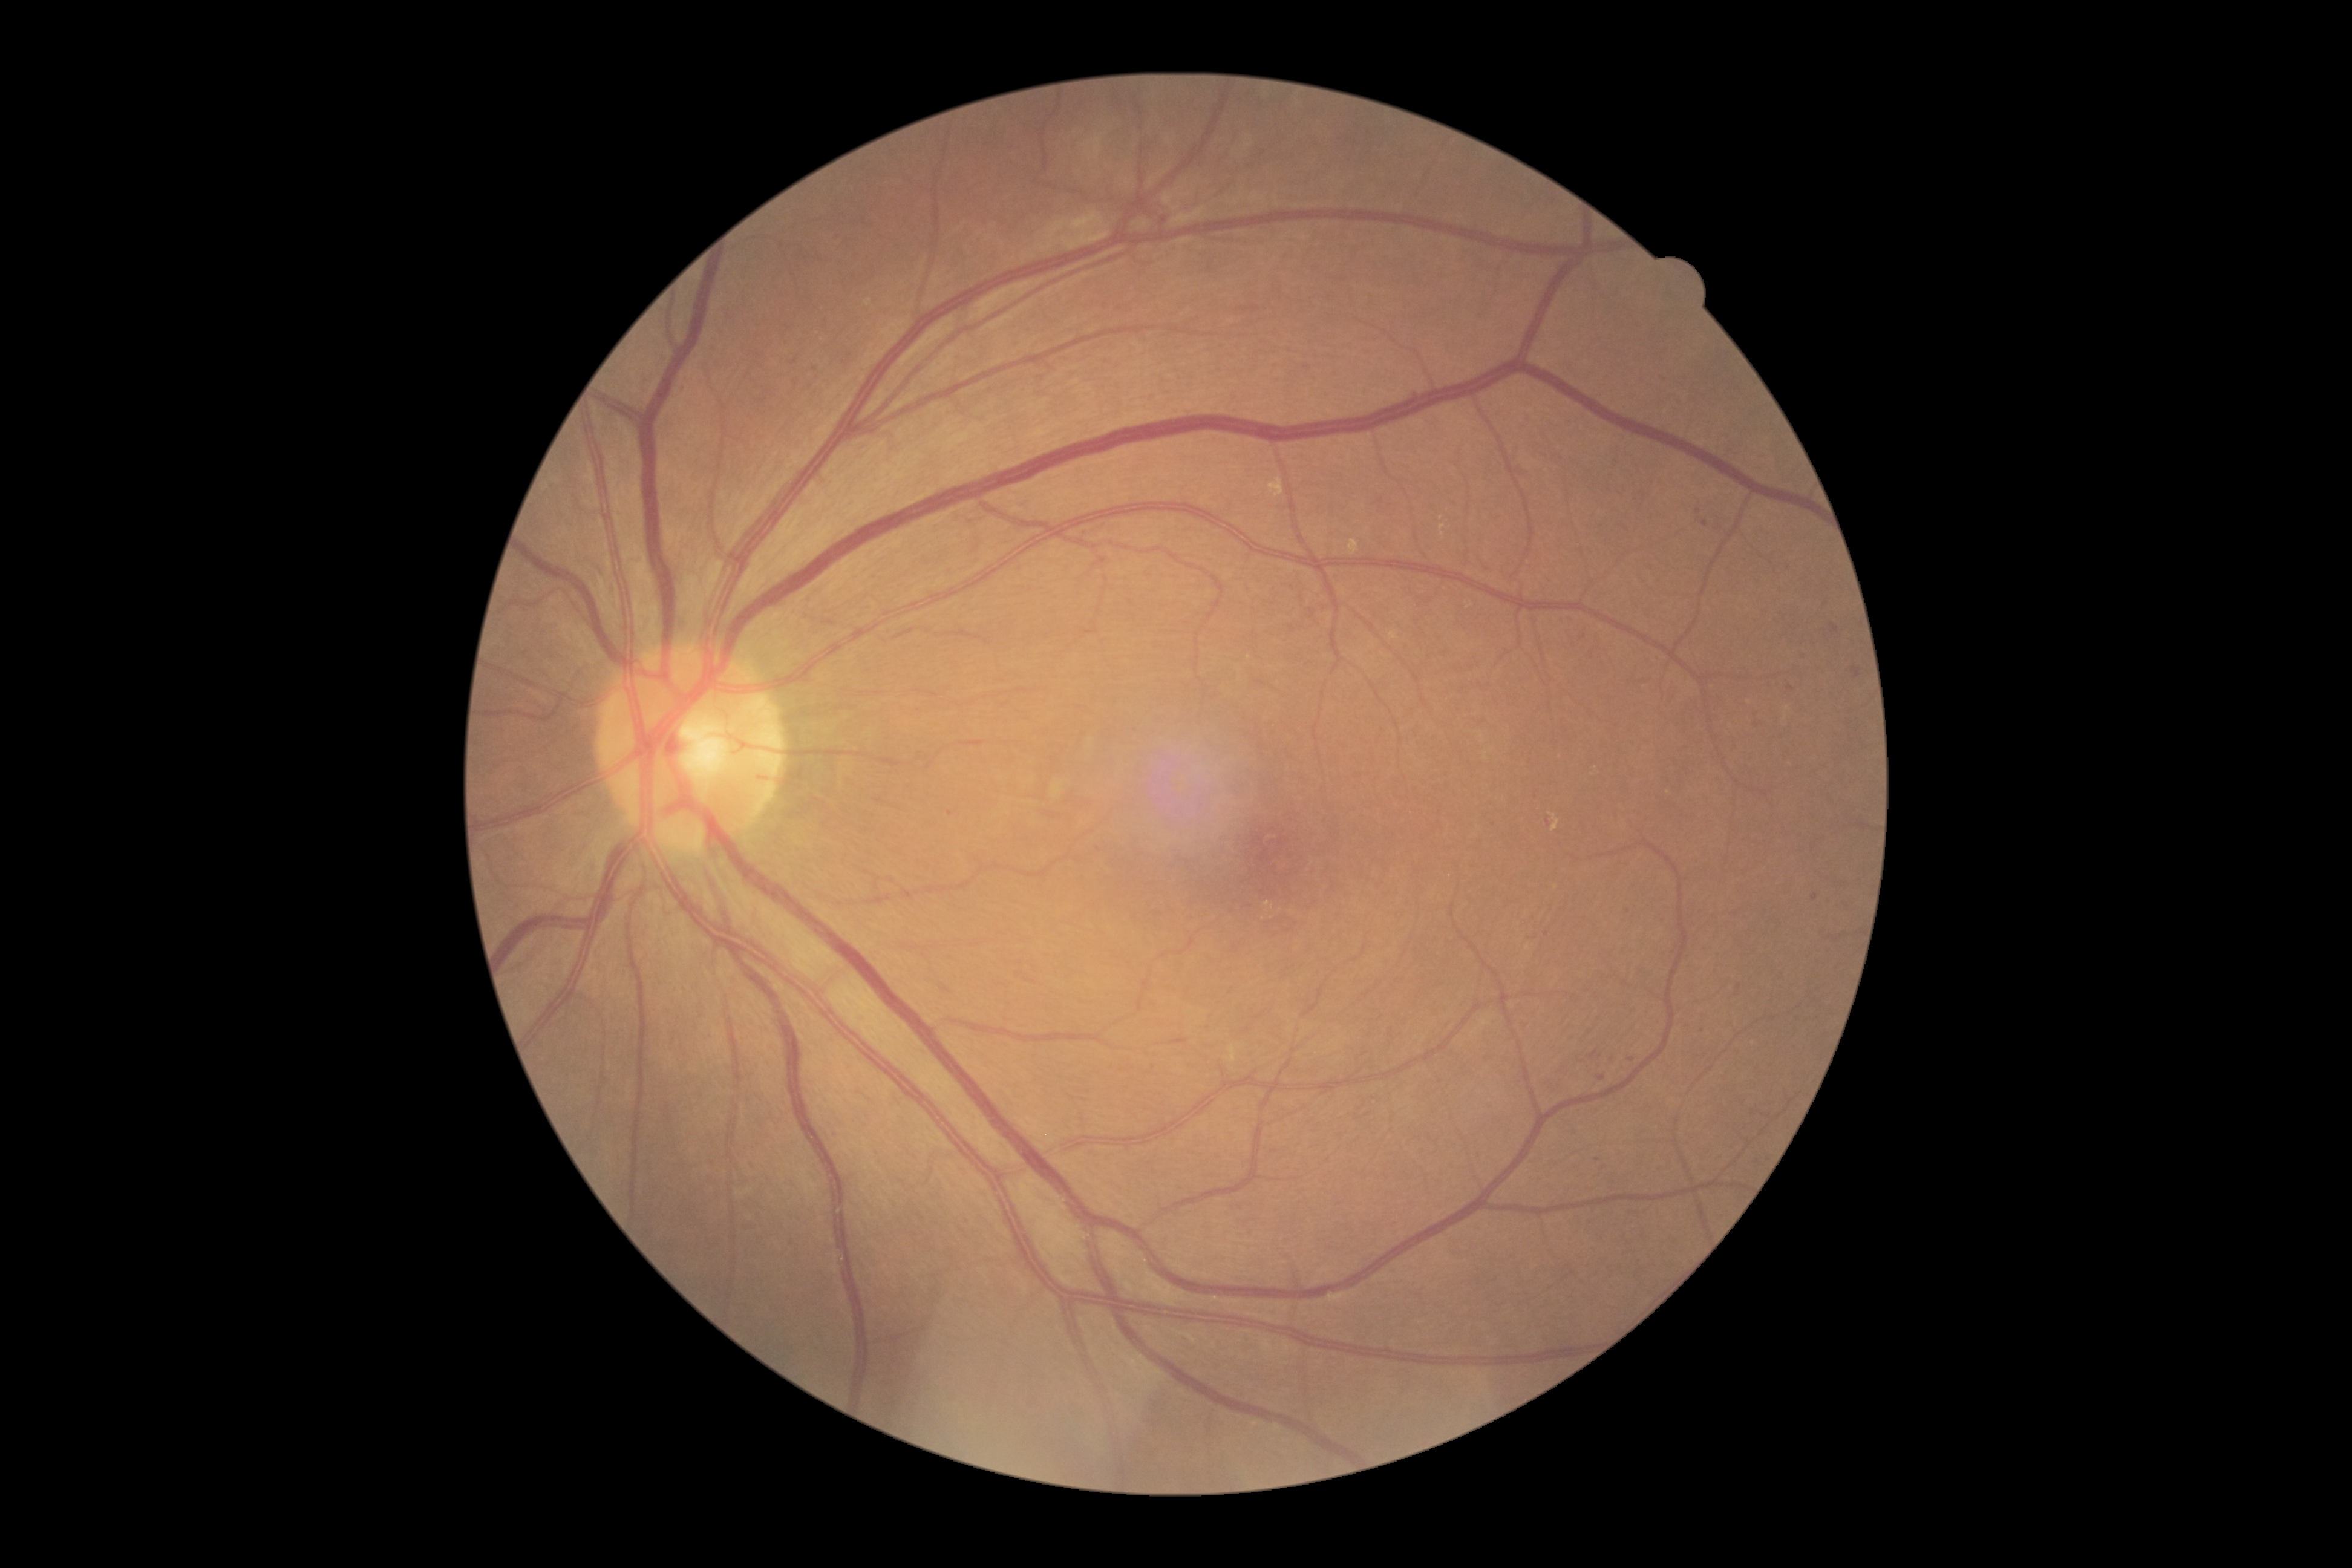

Retinopathy: grade 2 (moderate NPDR).